Color fundus image.
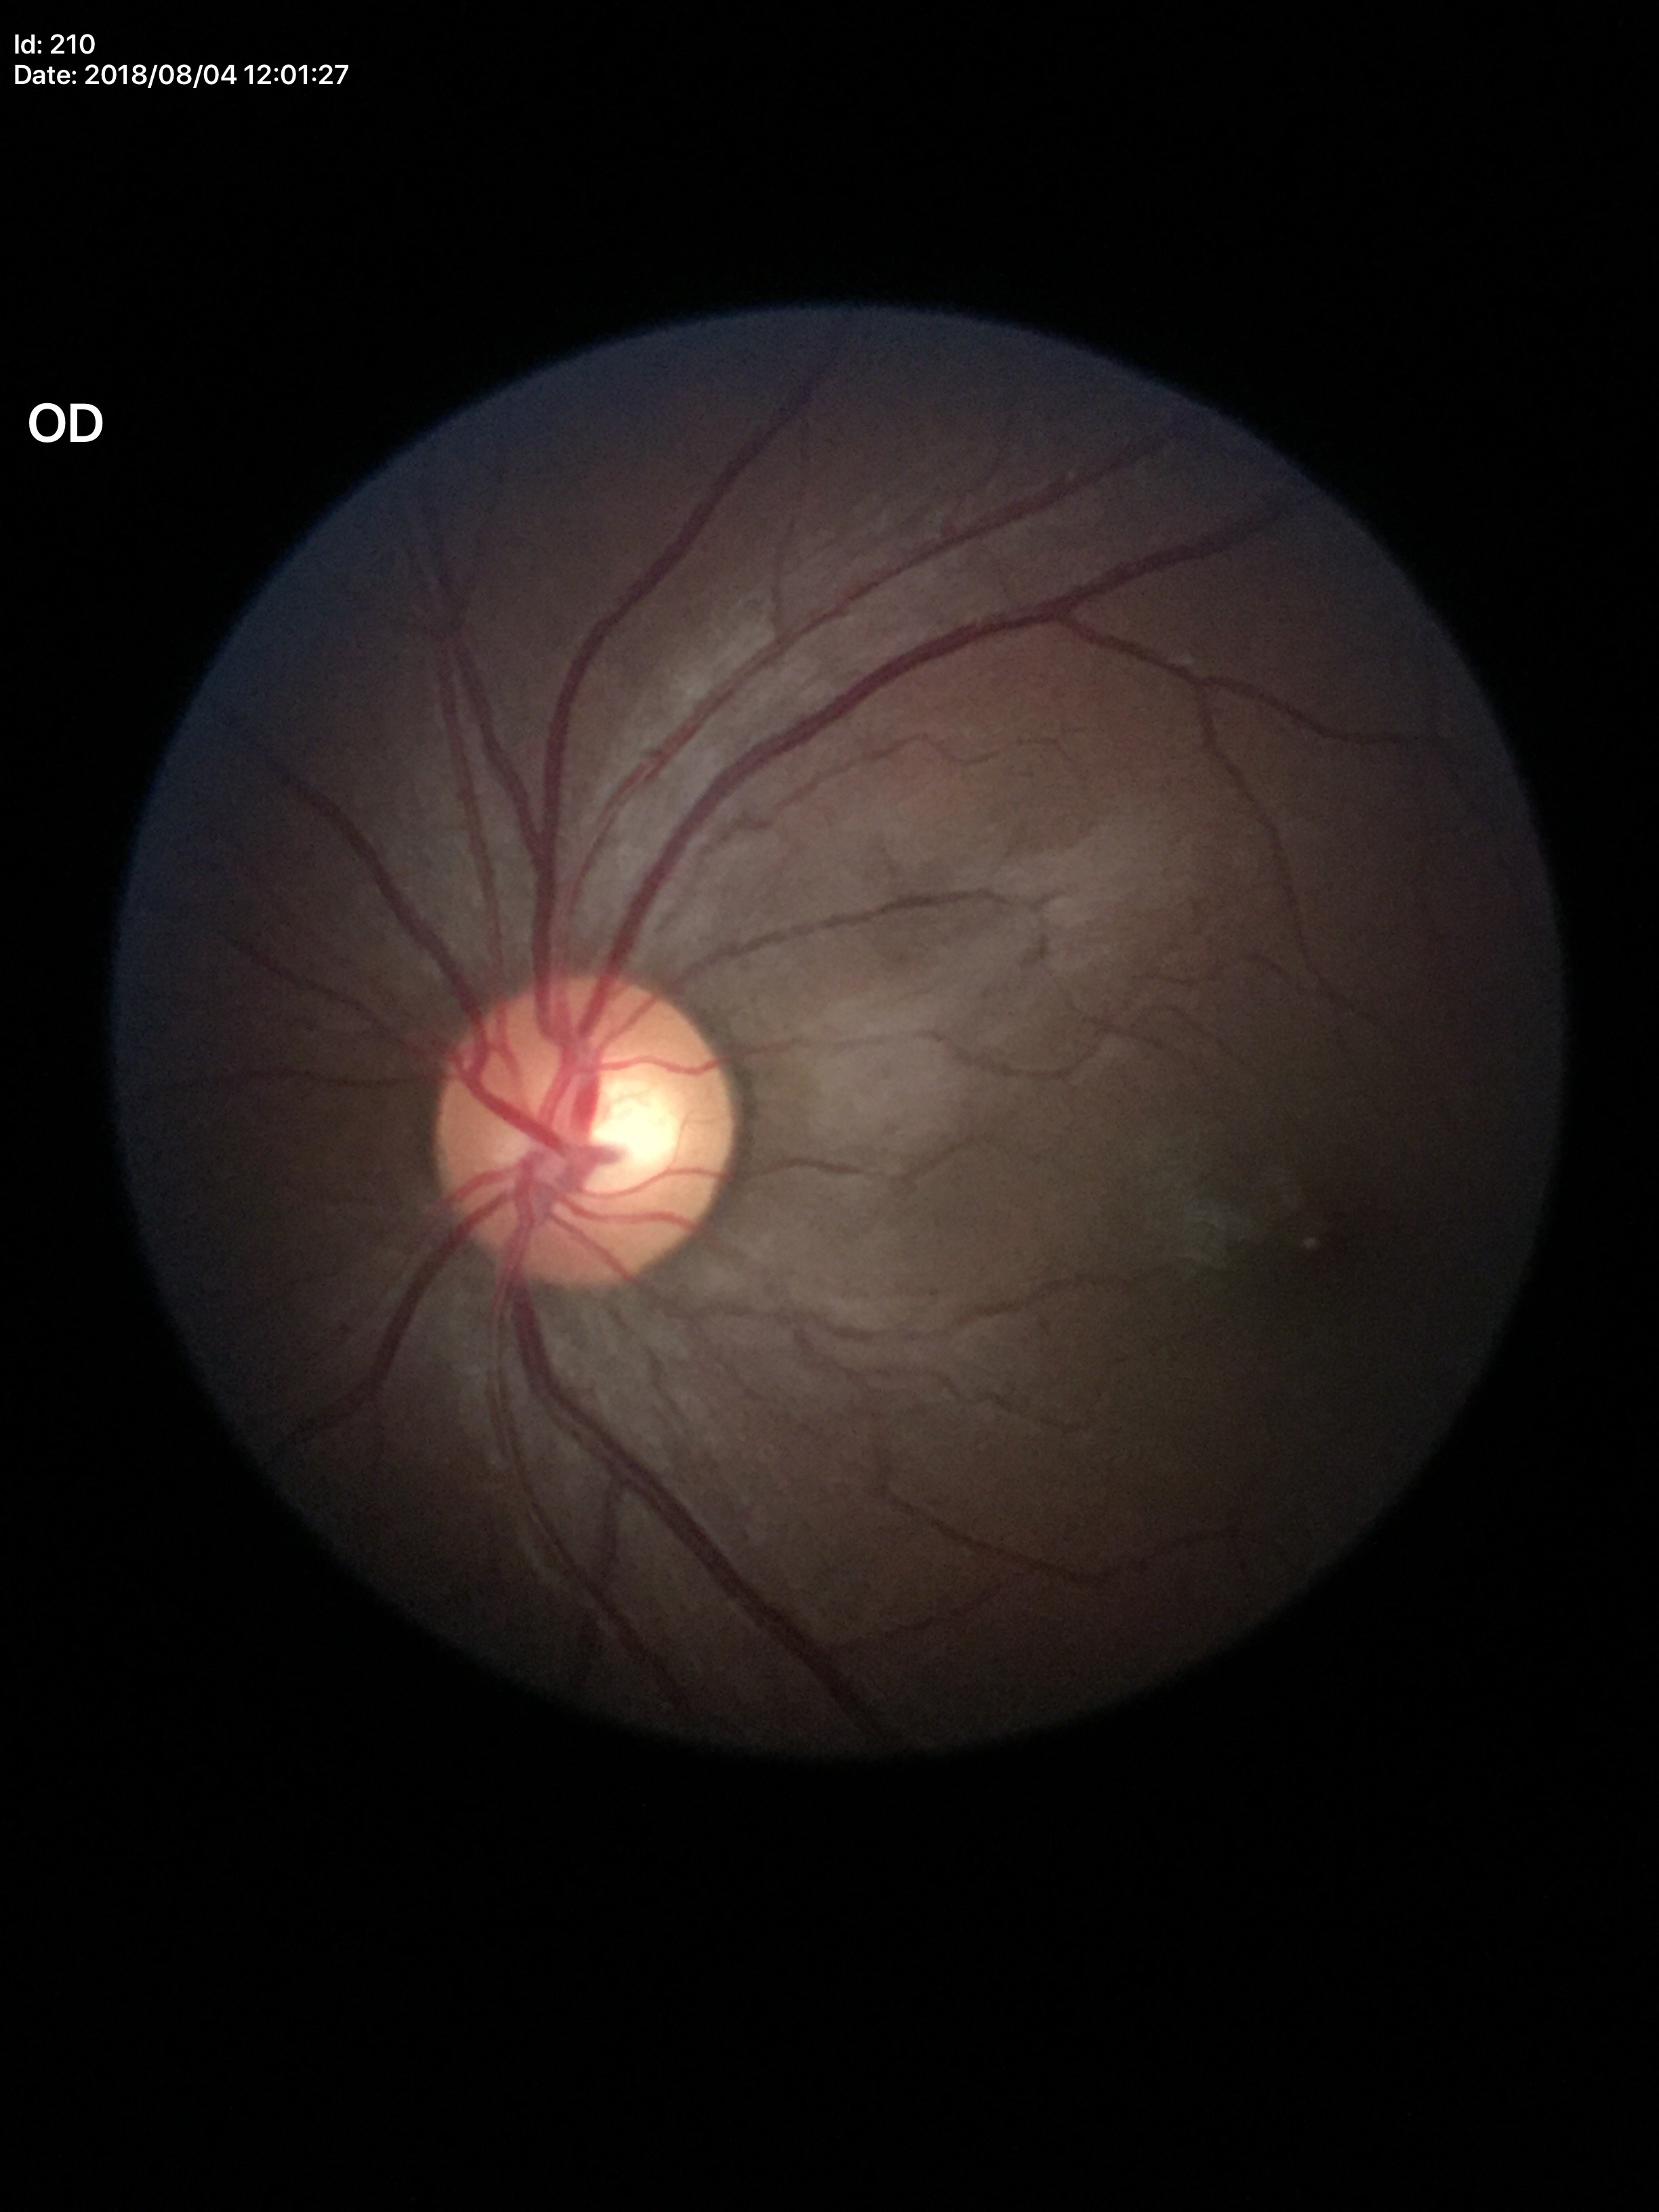
Q: What is the VCDR?
A: 0.55
Q: Is there glaucoma suspicion?
A: negative